Acquired on the Clarity RetCam 3 · image size 640x480 · wide-field fundus image from infant ROP screening — 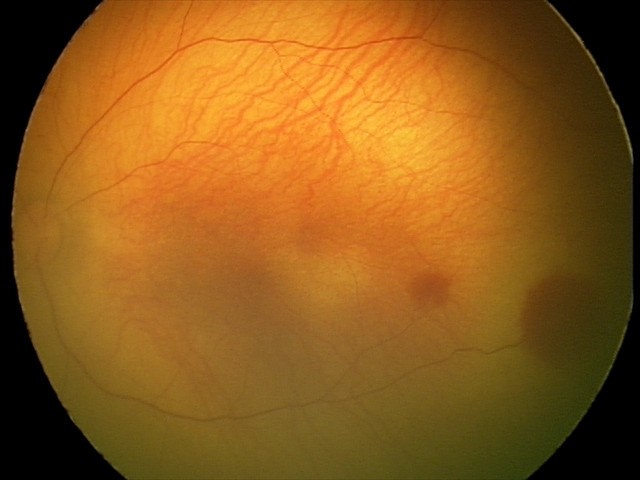 Q: What was the screening finding?
A: retinal hemorrhages